Image size 735x723. FOV: 45 degrees. CFP — 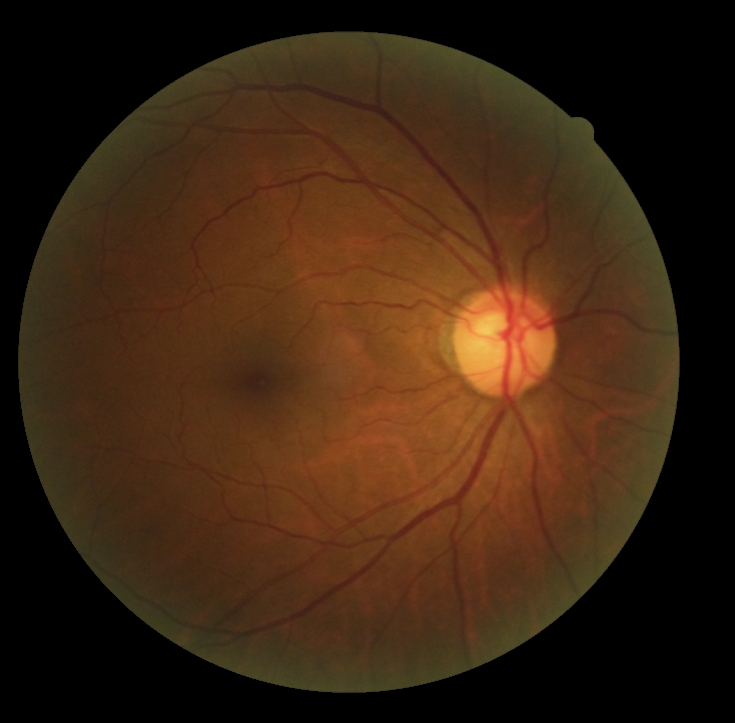
DR grade=no apparent diabetic retinopathy (0), DR impression=no DR findings.